Color fundus image:
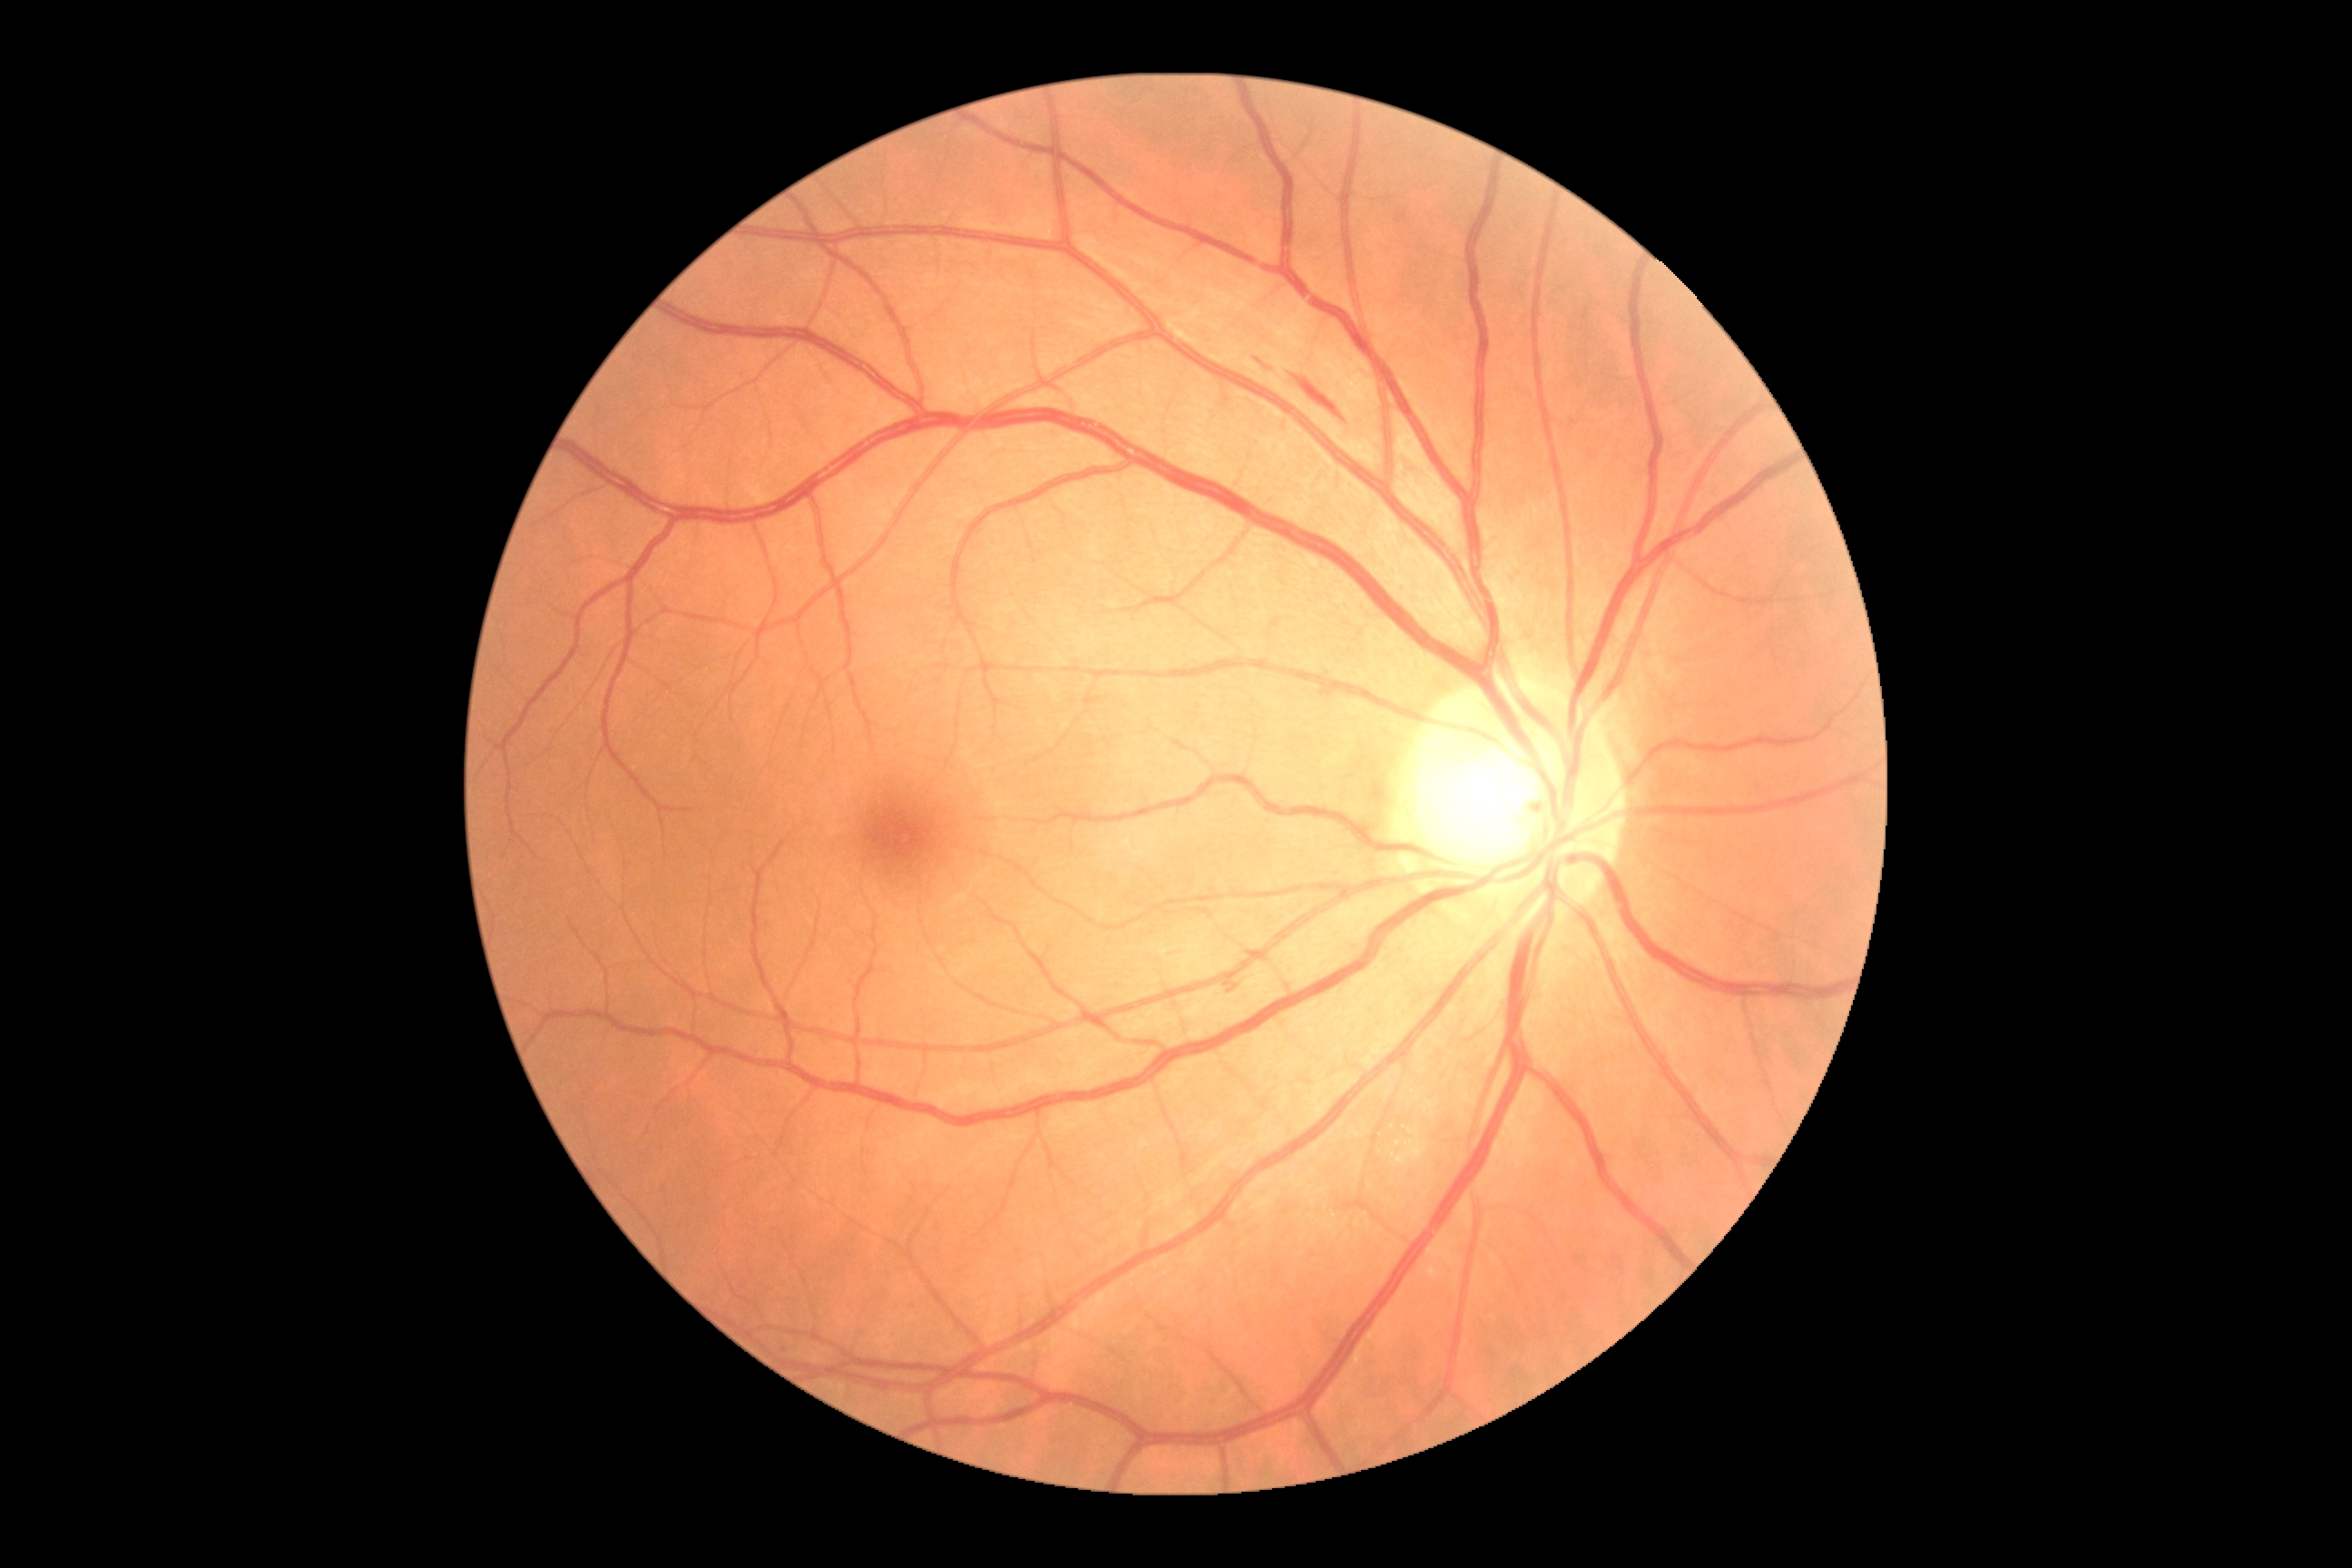
Findings:
– retinopathy grade: 2